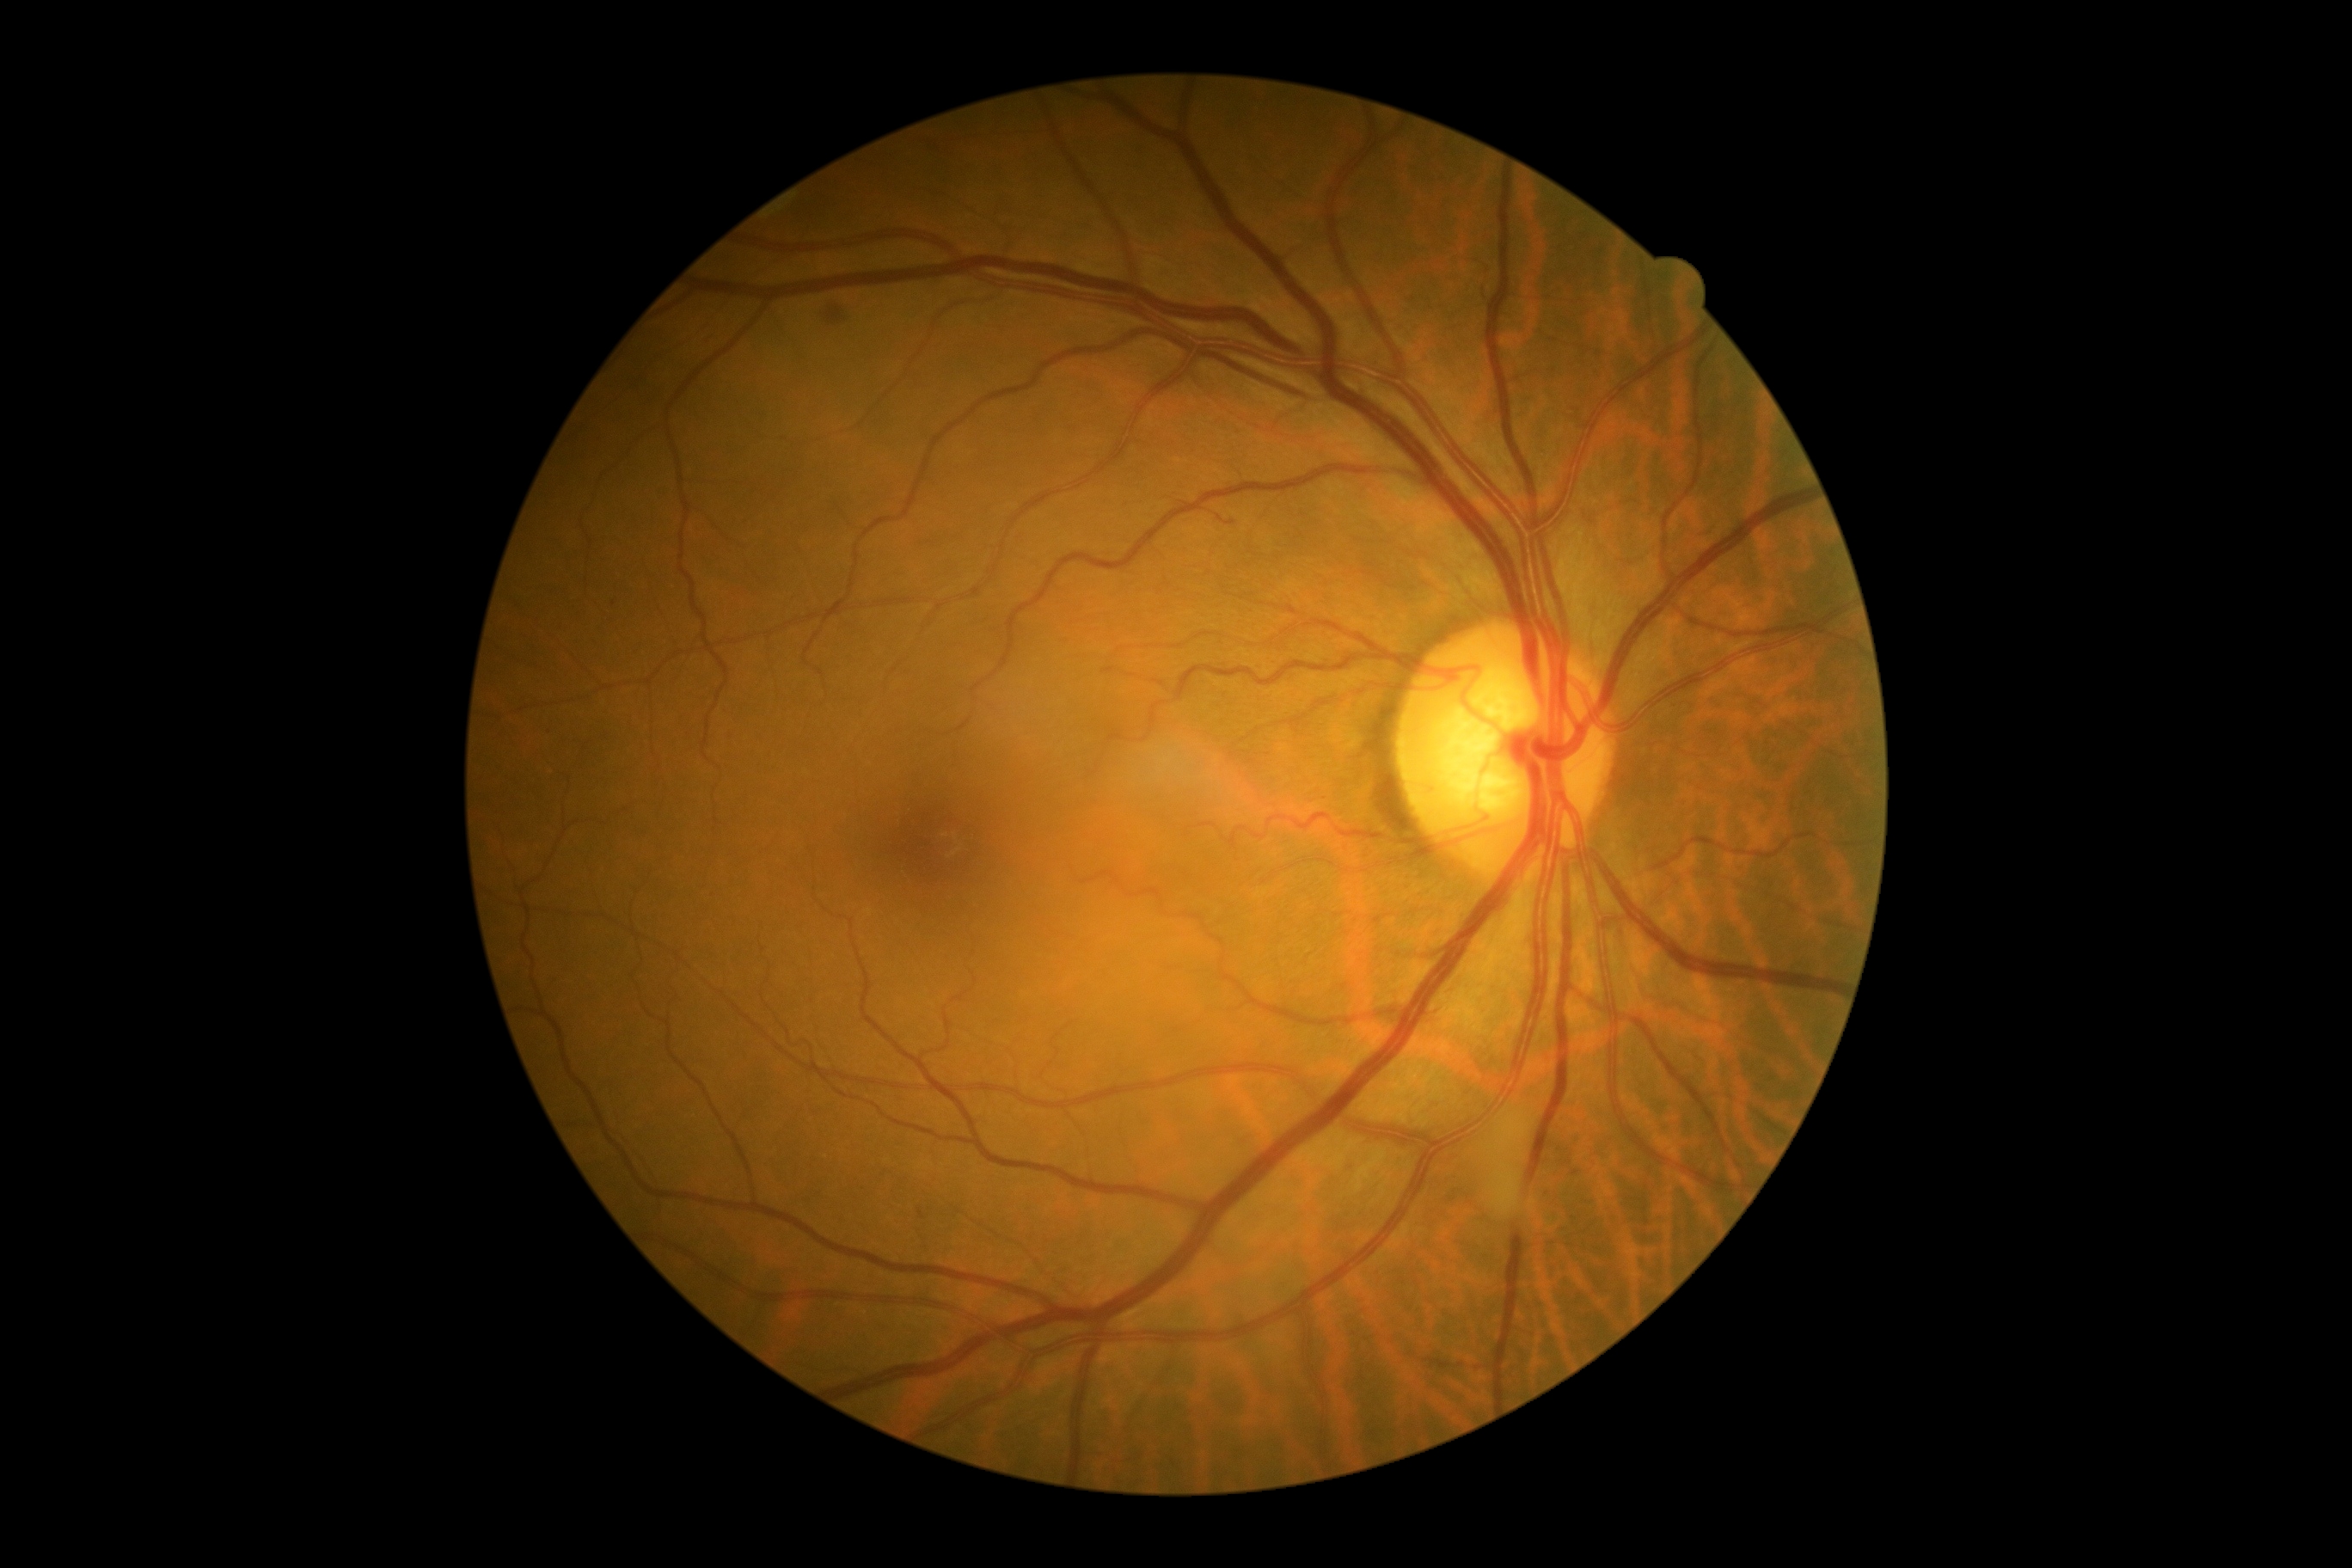
DR severity is grade 2 (moderate NPDR).
No EXs identified.
HEs identified at (left=826, top=309, right=845, bottom=326).
No SEs identified.